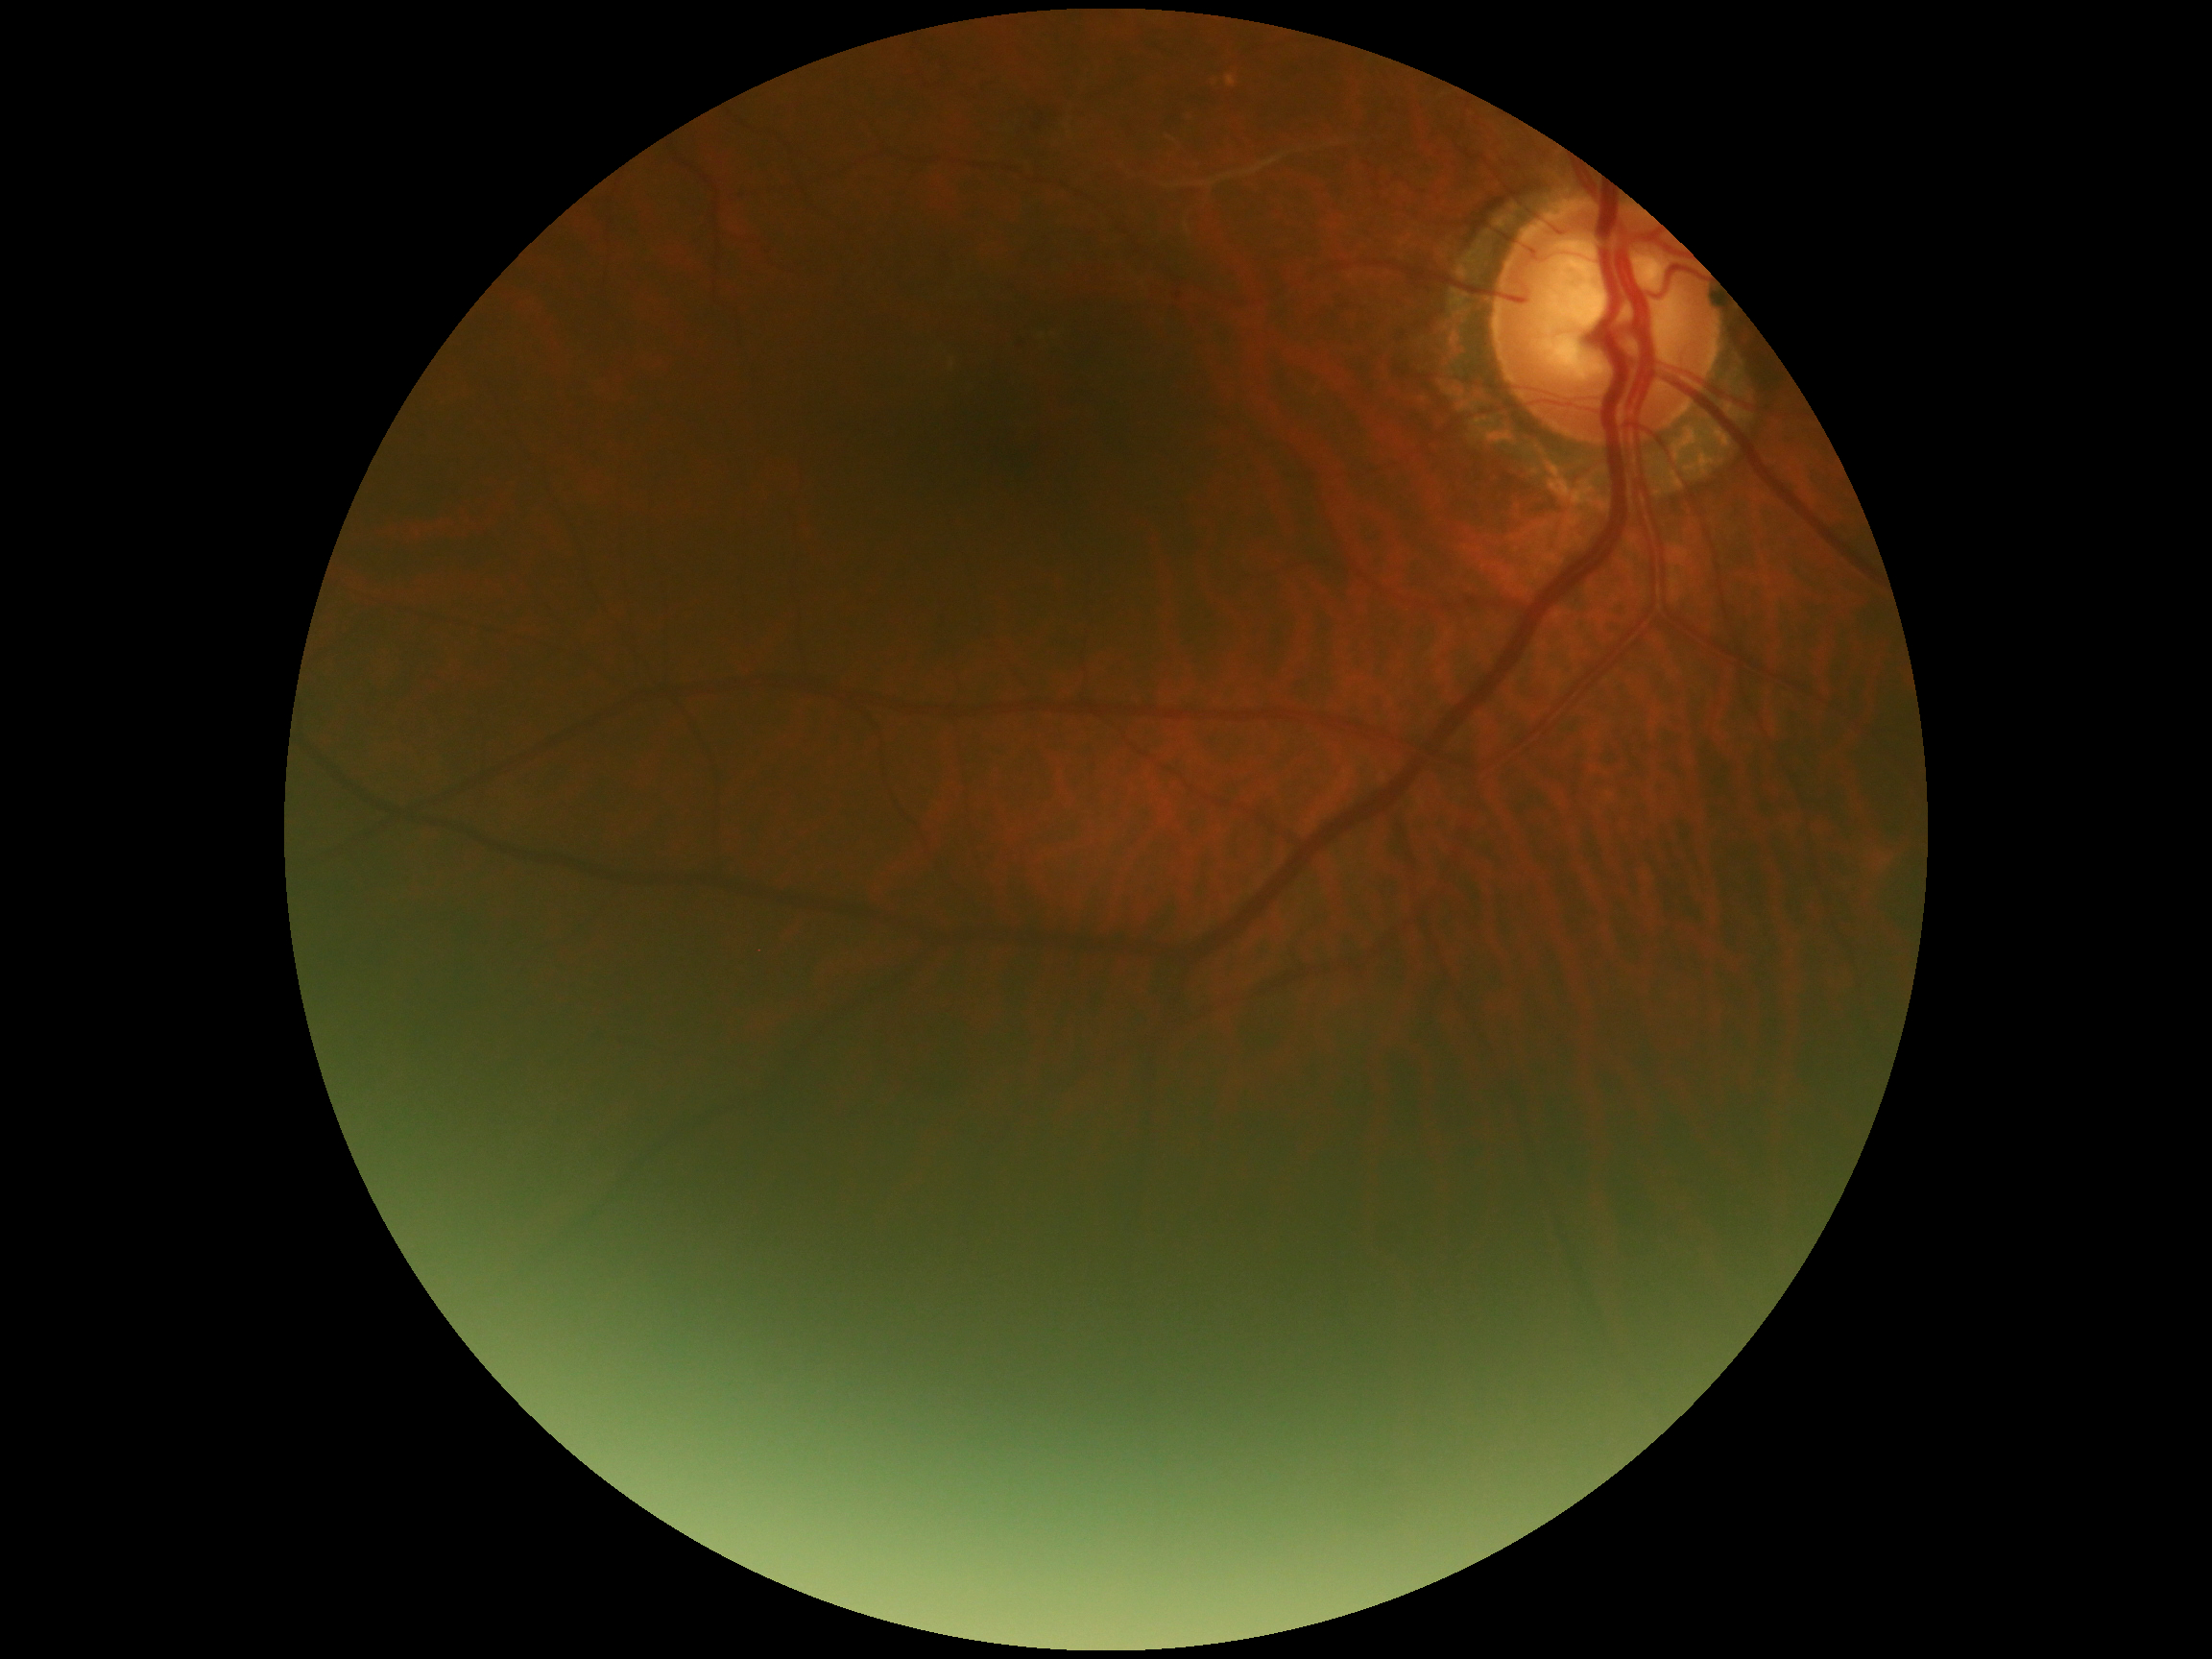 Retinopathy is grade 2 (moderate NPDR).